Posterior pole color fundus photograph. 45° FOV
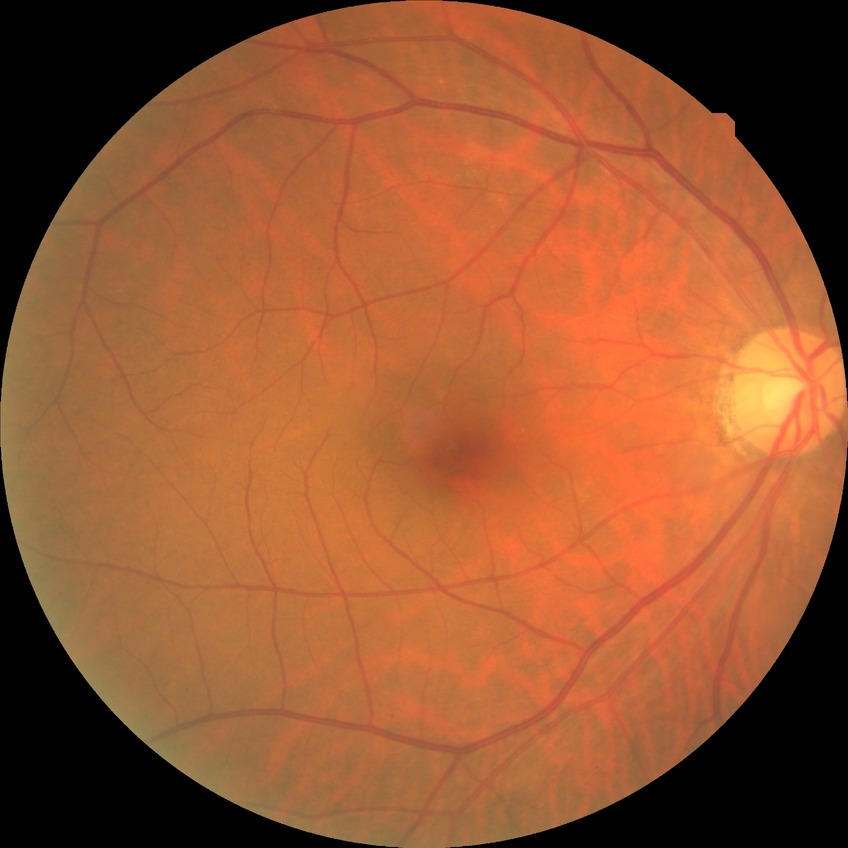 davis_grade: NDR (no diabetic retinopathy)